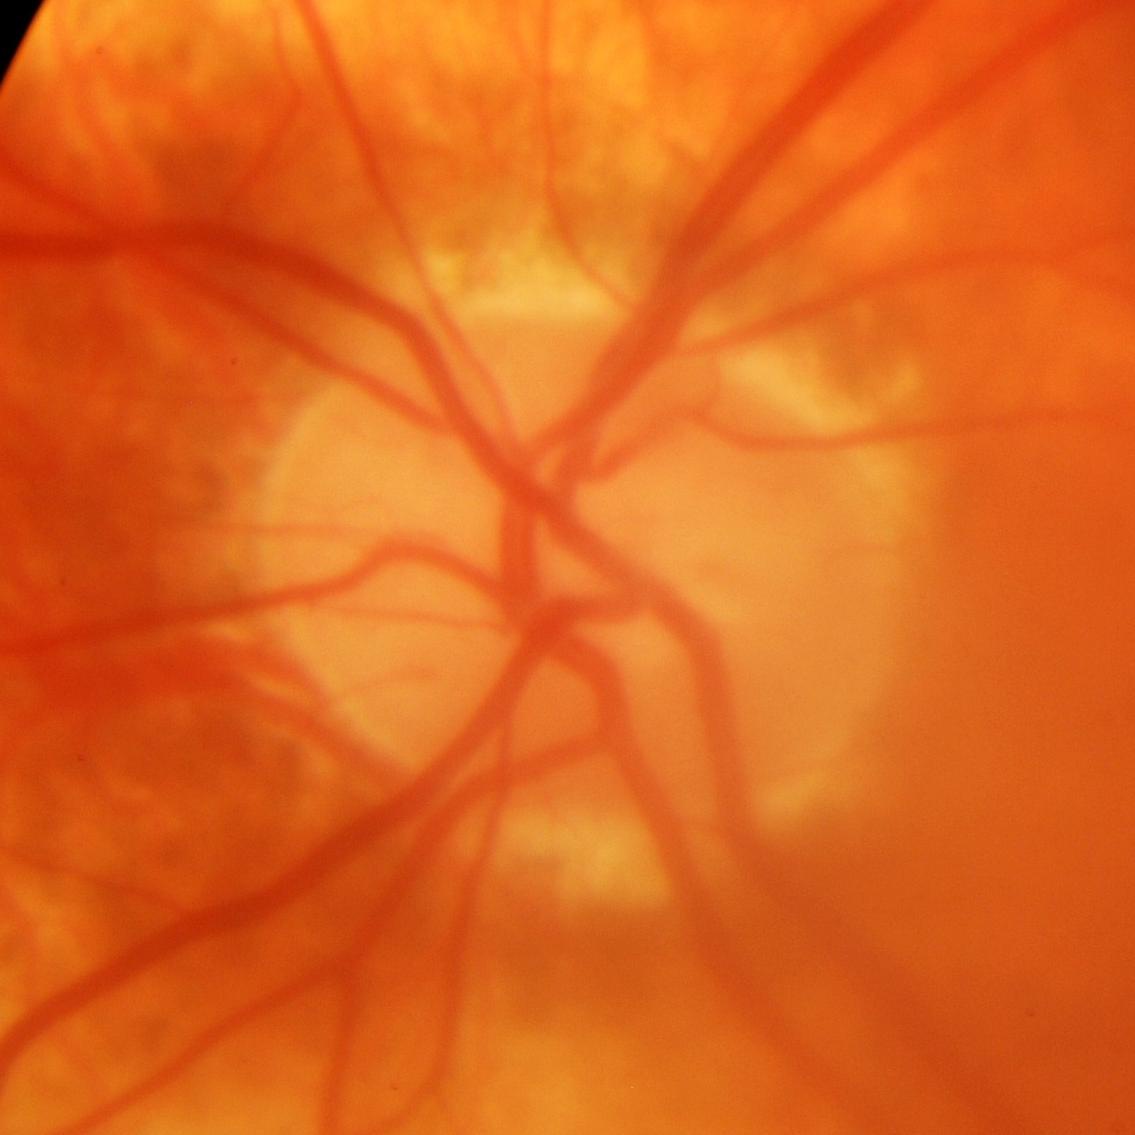
Glaucomatous changes.